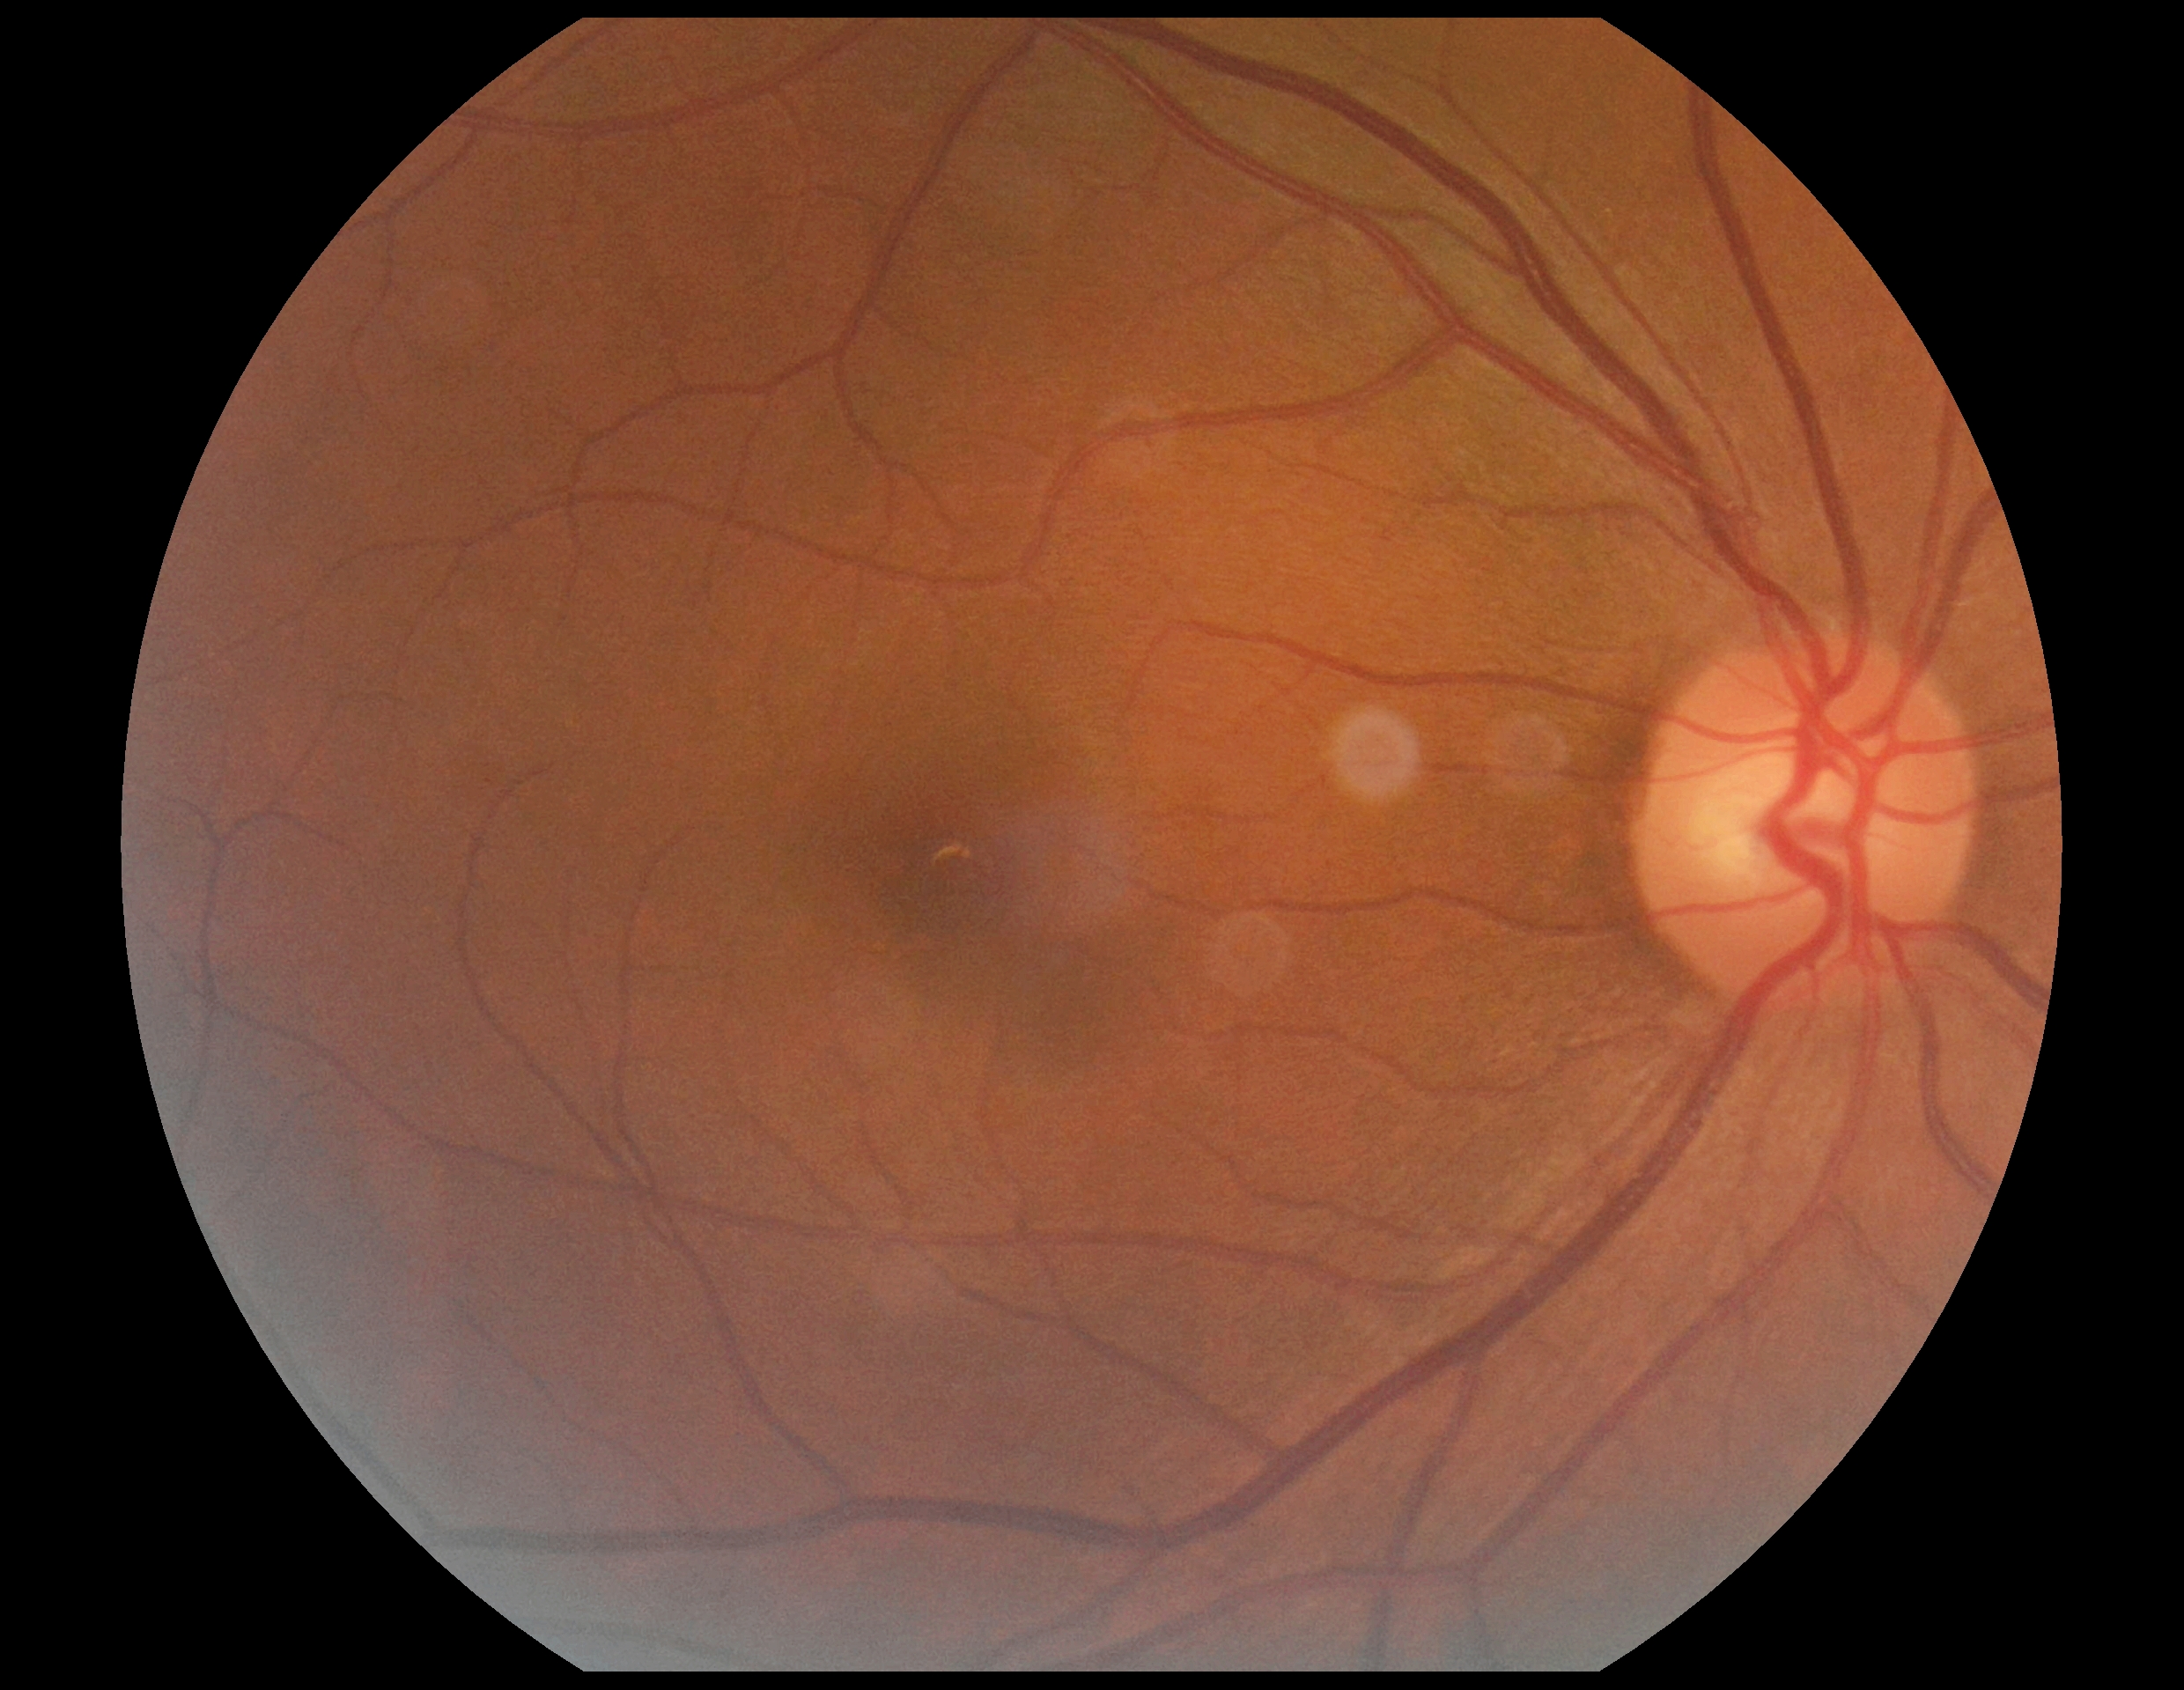
- DR impression: negative for DR
- diabetic retinopathy (DR): 0/4